45° field of view, 2048 x 1536 pixels — 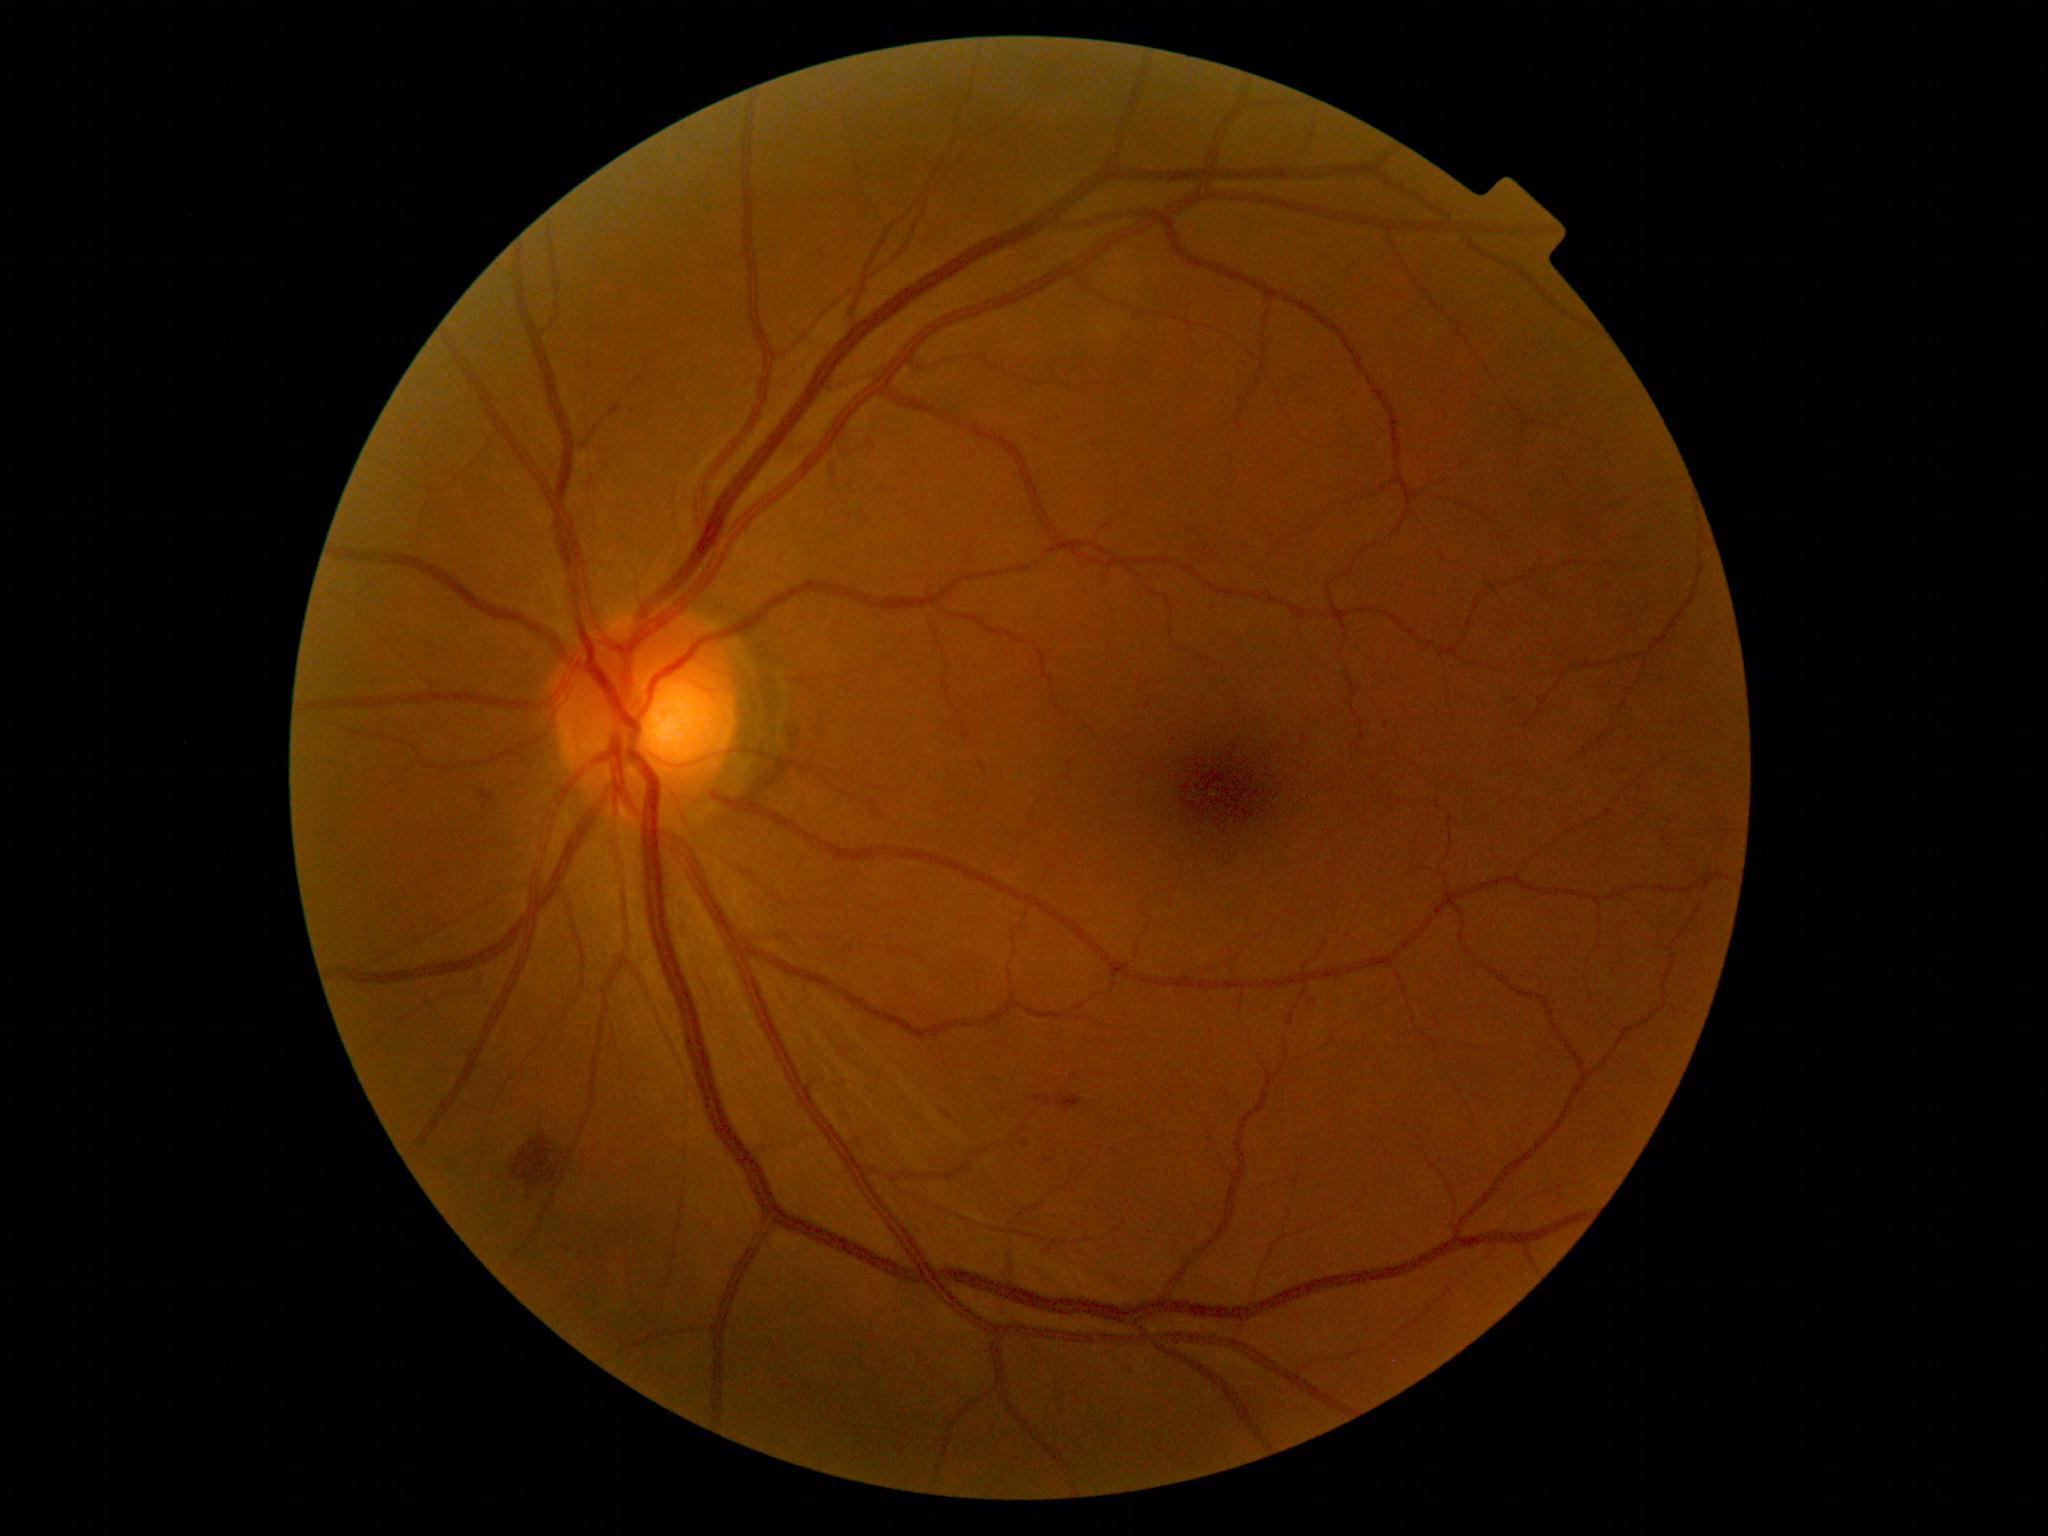
Diabetic retinopathy (DR): grade 2
Lesions:
- soft exudates (SEs): none identified
- hard exudates (EXs): none identified
- microaneurysms (MAs): none identified
- hemorrhages (HEs): l=465, t=785, r=499, b=818, l=1036, t=1096, r=1082, b=1113, l=1022, t=1143, r=1030, b=1147, l=512, t=1137, r=558, b=1187